NIDEK AFC-230 · CFP · no pharmacologic dilation · 848 by 848 pixels — 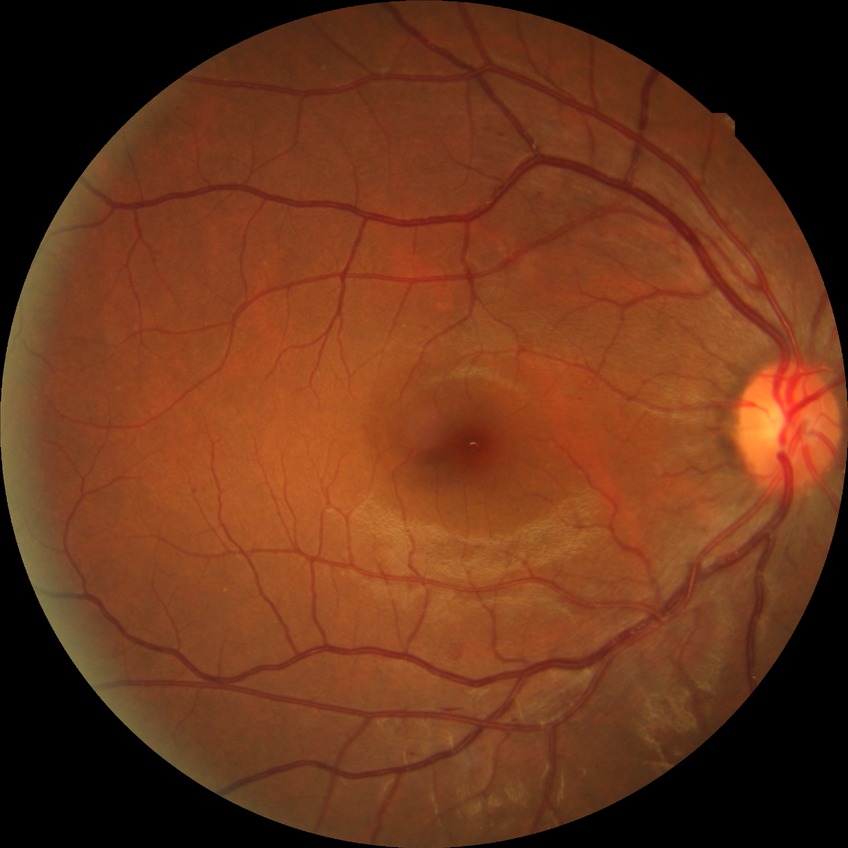

retinopathy grade=simple diabetic retinopathy.